2352x1568. Color fundus image — 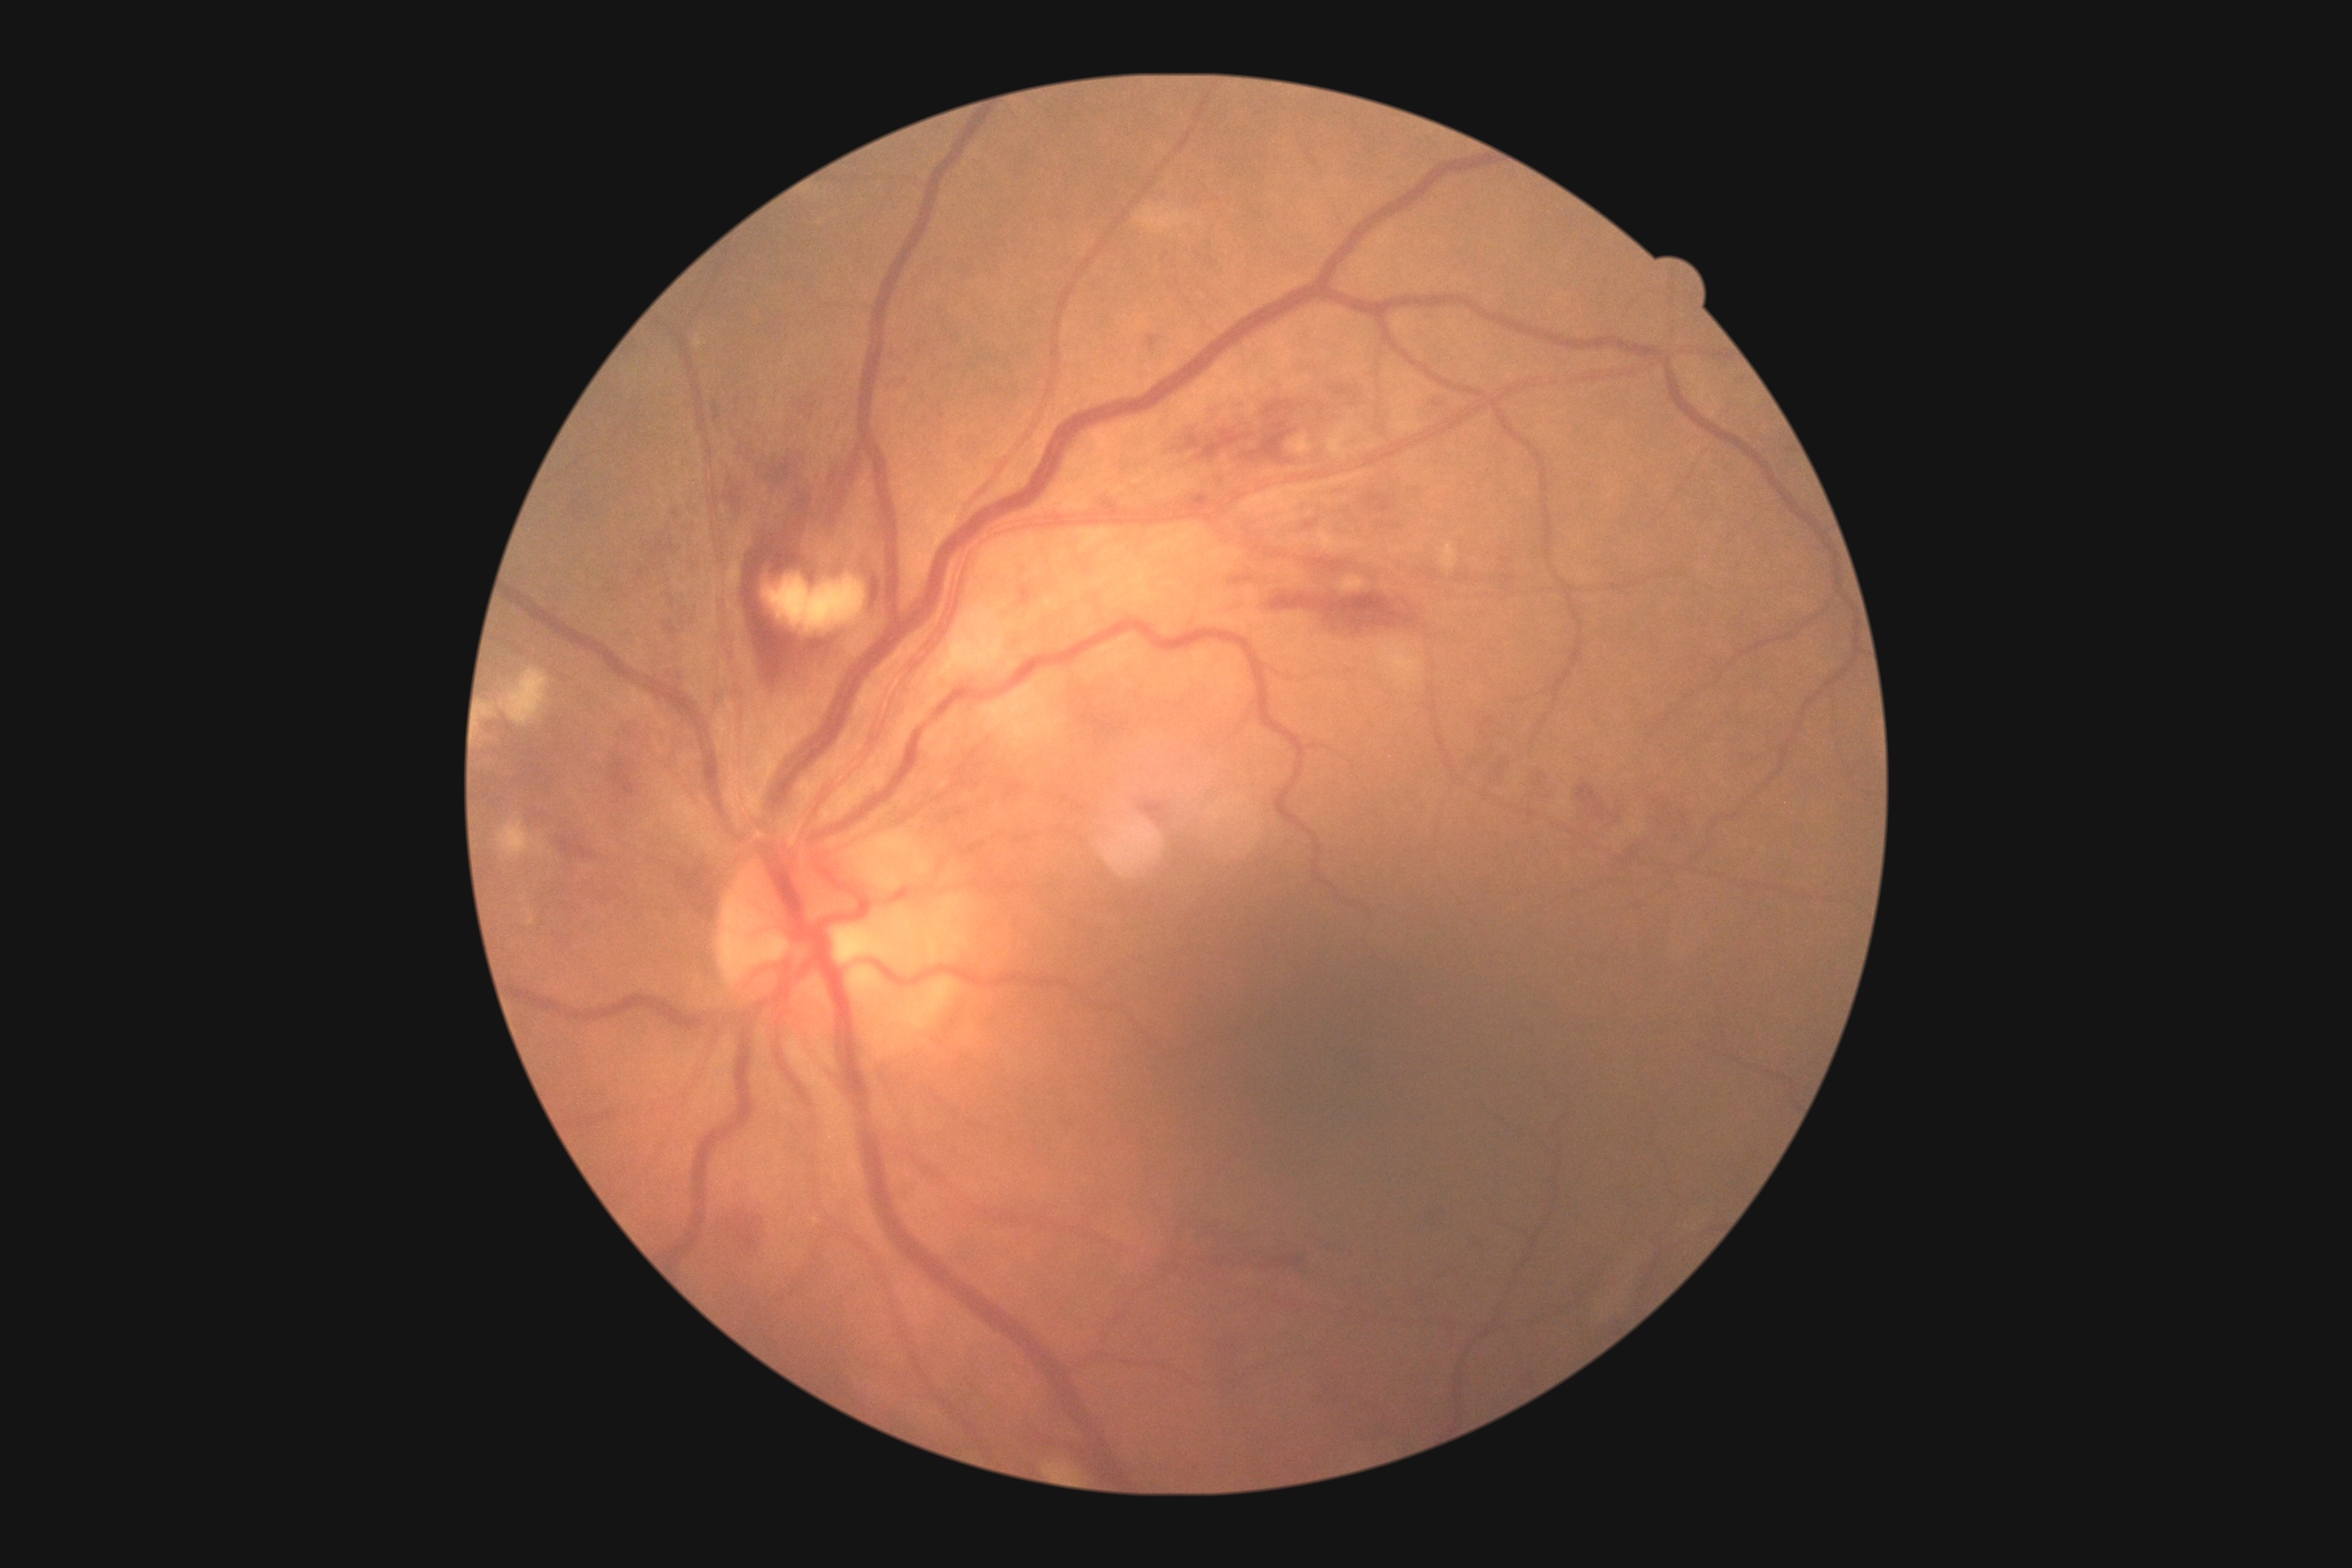 DR class = non-proliferative diabetic retinopathy; diabetic retinopathy severity = 2/4.